FOV: 45 degrees
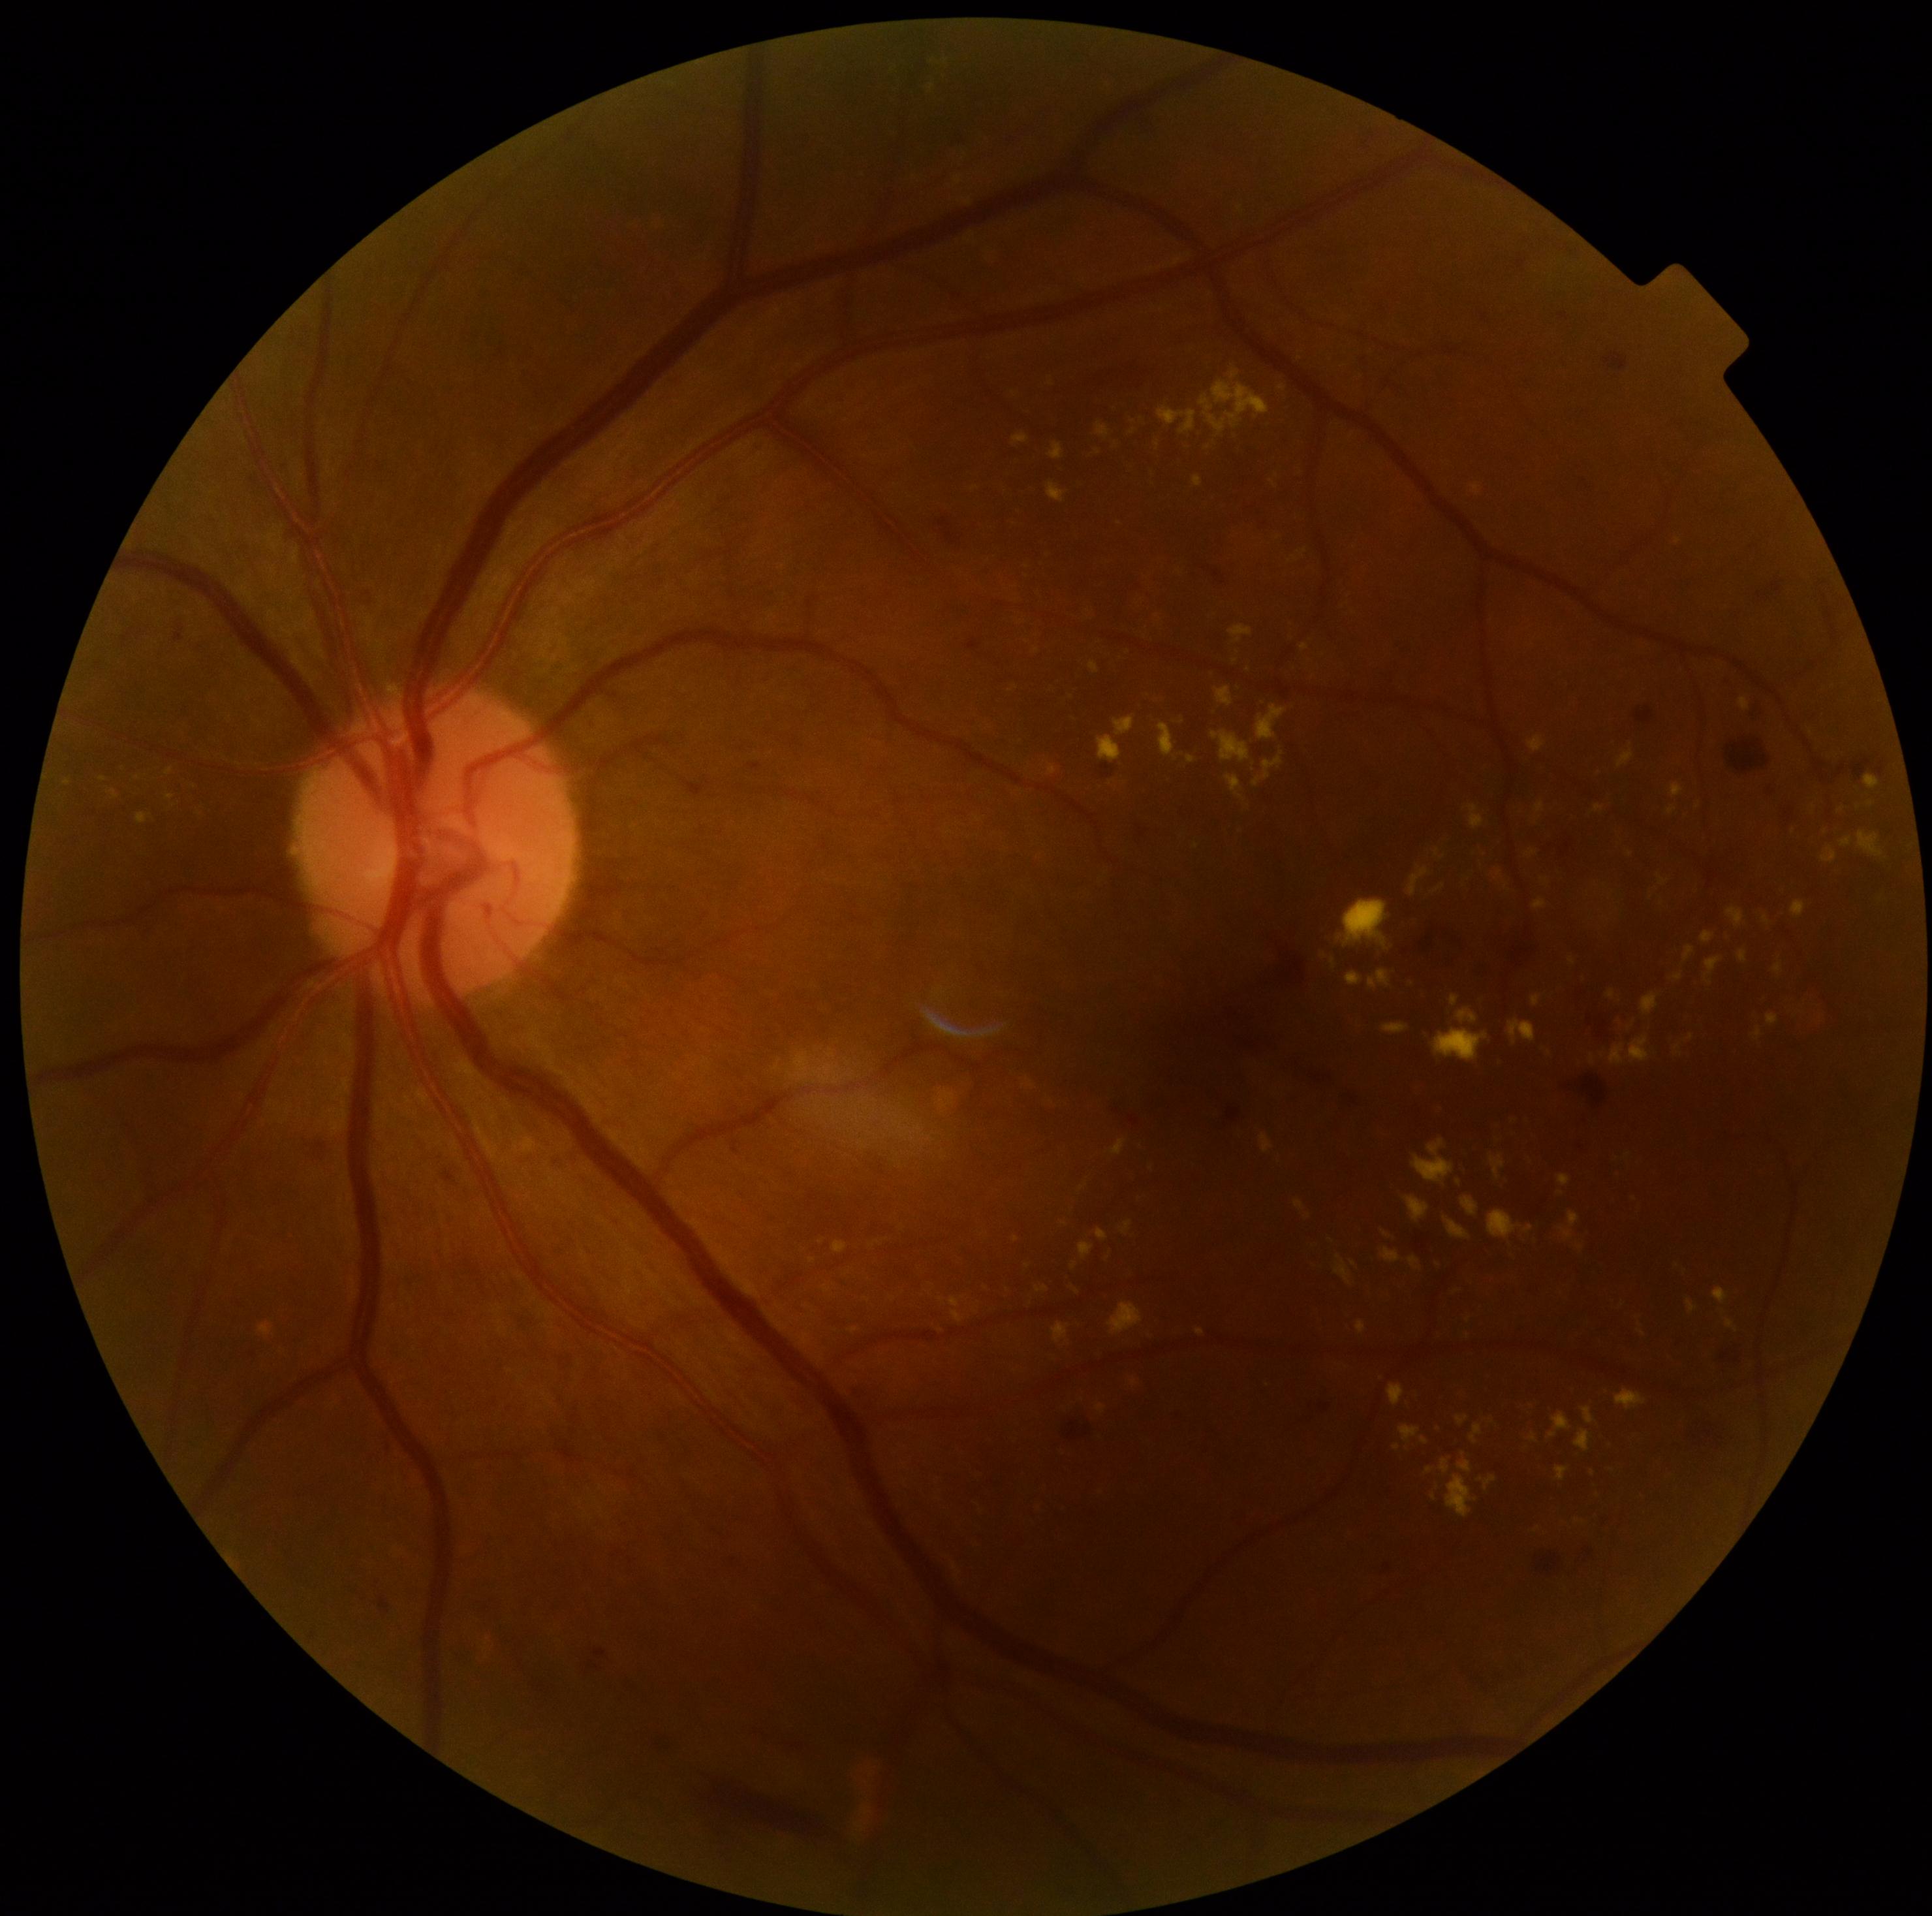
partial: true
dr_grade: 2
dr_grade_name: moderate NPDR
lesions:
  ex:
    - bbox=[1670, 782, 1683, 799]
    - bbox=[1272, 480, 1277, 488]
    - bbox=[1469, 804, 1485, 829]
    - bbox=[1439, 1460, 1451, 1474]
    - bbox=[1194, 477, 1203, 488]
    - bbox=[1187, 756, 1195, 764]
    - bbox=[1350, 1260, 1357, 1268]
    - bbox=[1335, 1255, 1352, 1286]
    - bbox=[1473, 484, 1481, 496]
    - bbox=[1357, 1321, 1367, 1334]
    - bbox=[1615, 1388, 1647, 1410]
    - bbox=[1412, 1139, 1455, 1186]
    - bbox=[1216, 688, 1234, 706]
    - bbox=[1713, 1287, 1729, 1304]
  ex_small_centers:
    - 867, 1301
    - 820, 1360
    - 1052, 384
    - 1580, 1247